2352 x 1568 pixels.
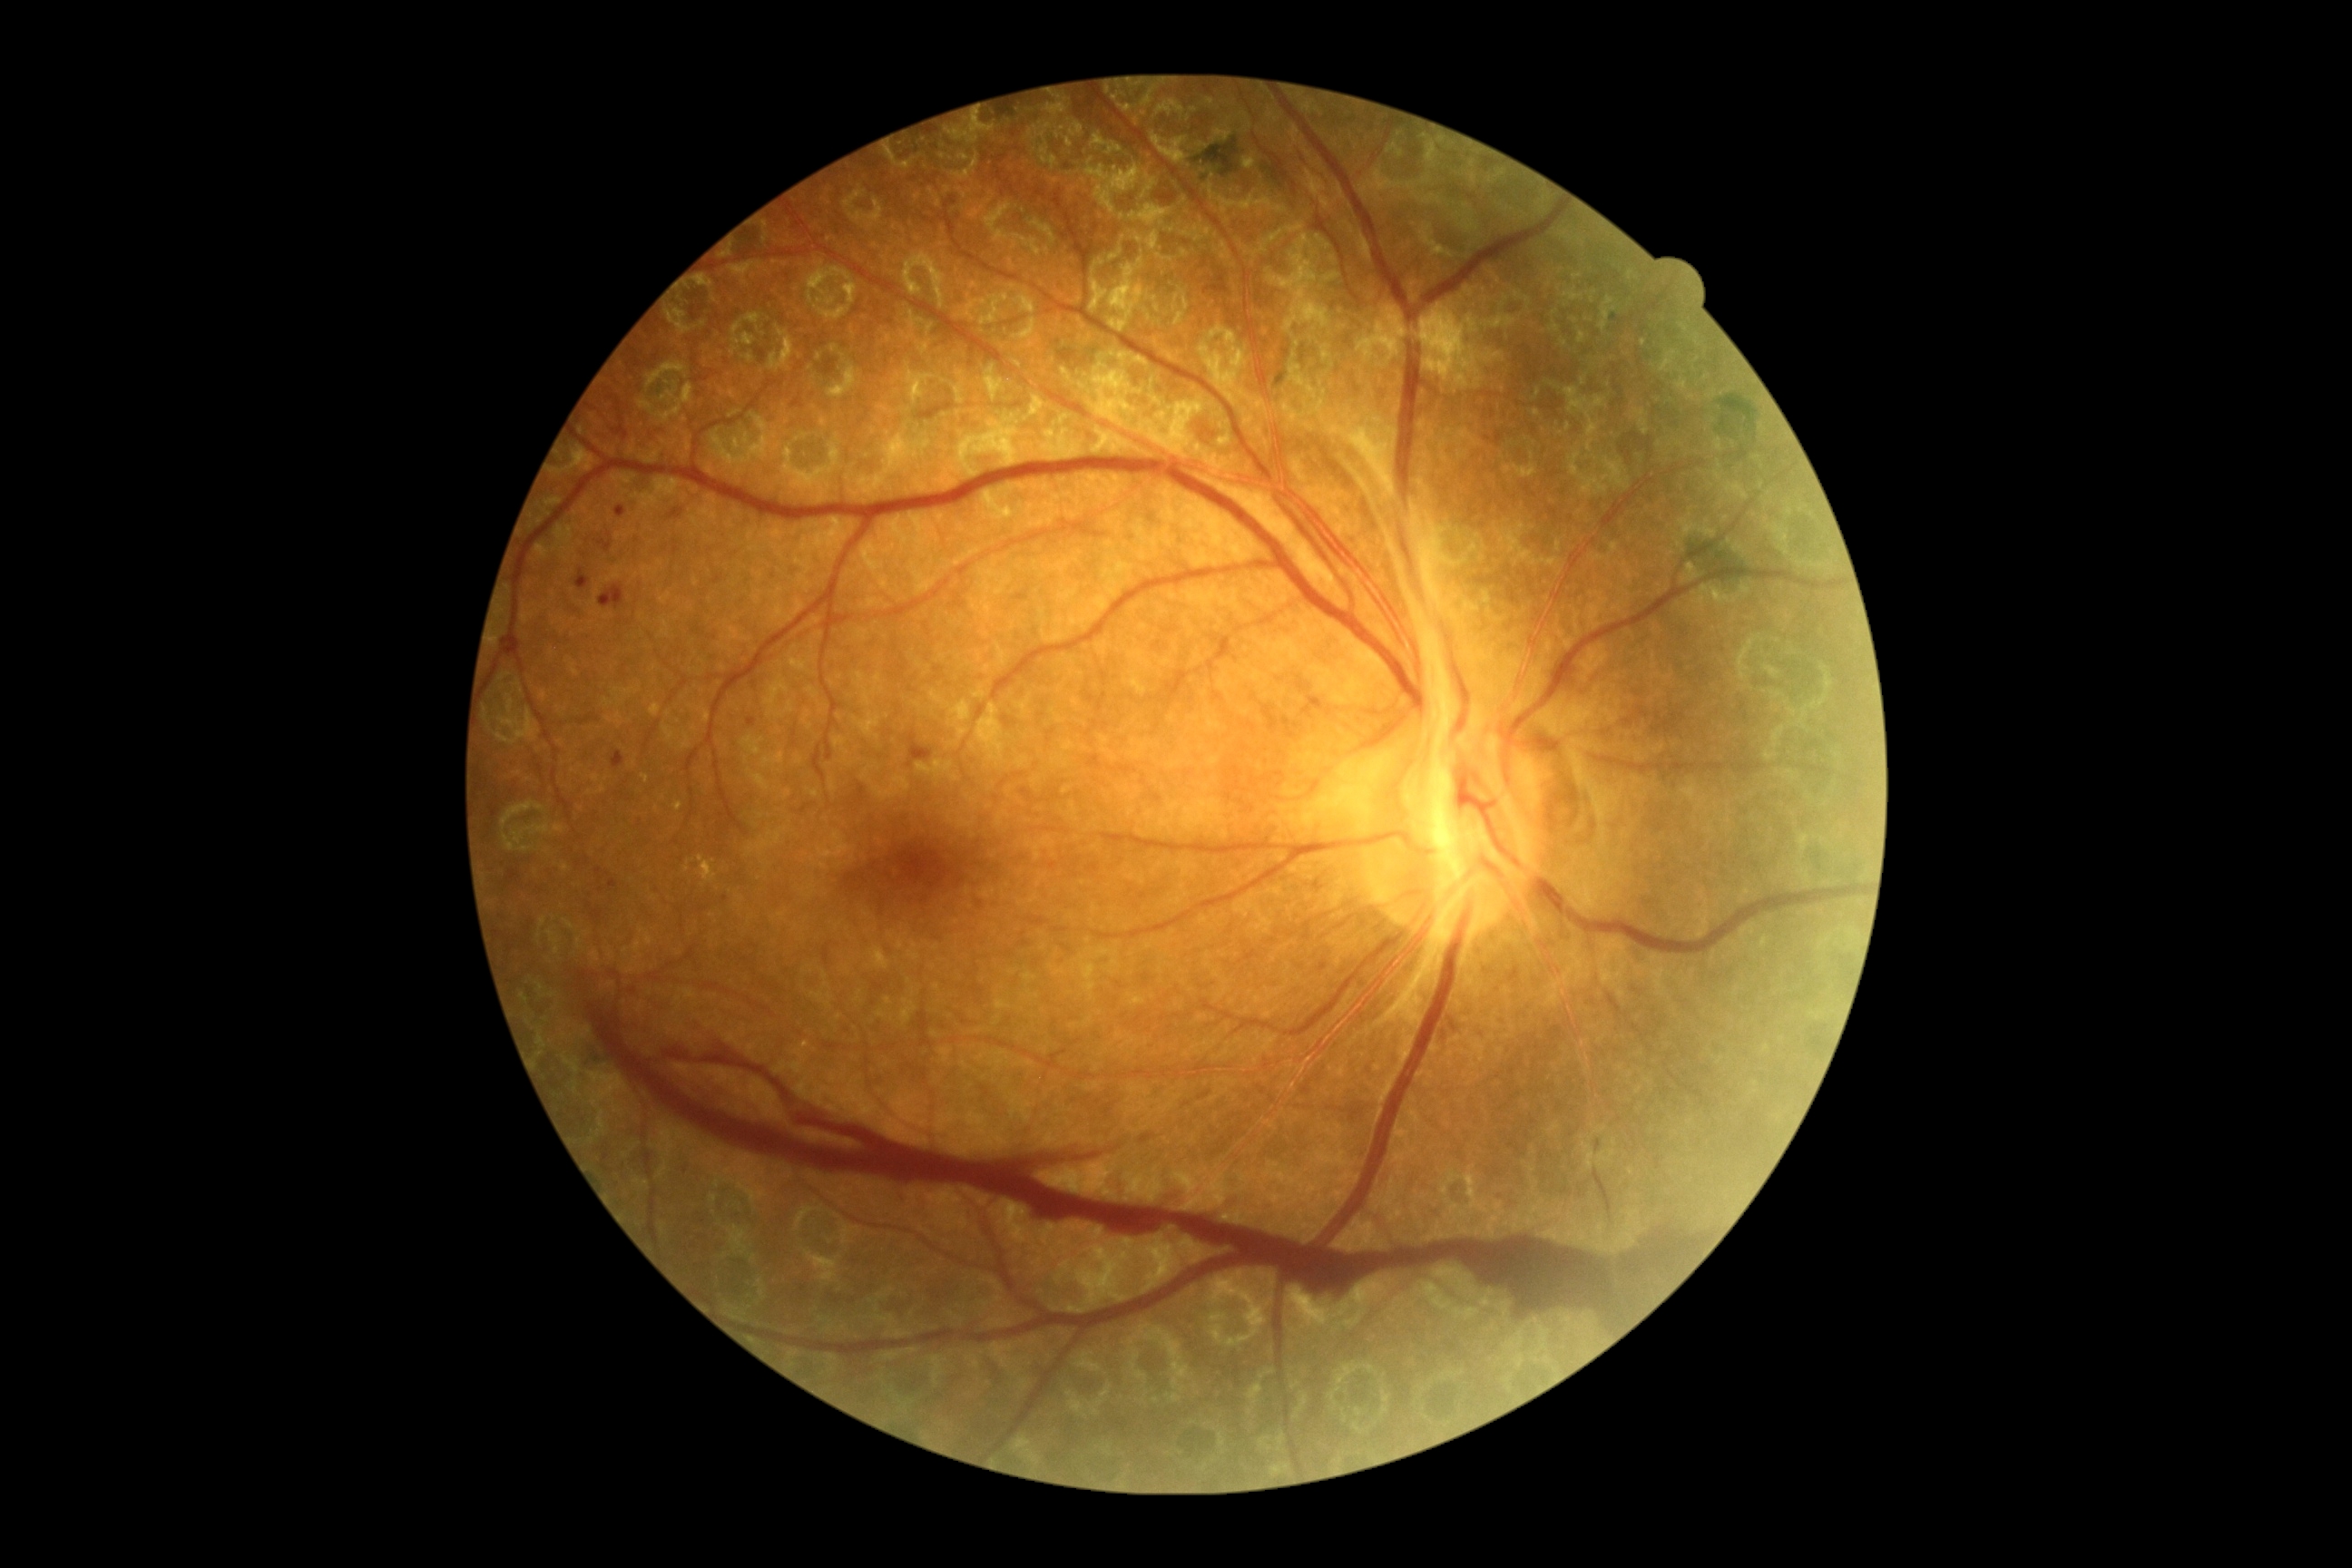

retinopathy grade: 4 (PDR) — neovascularization and/or vitreous/pre-retinal hemorrhage.